Without pupil dilation · 45° FOV: 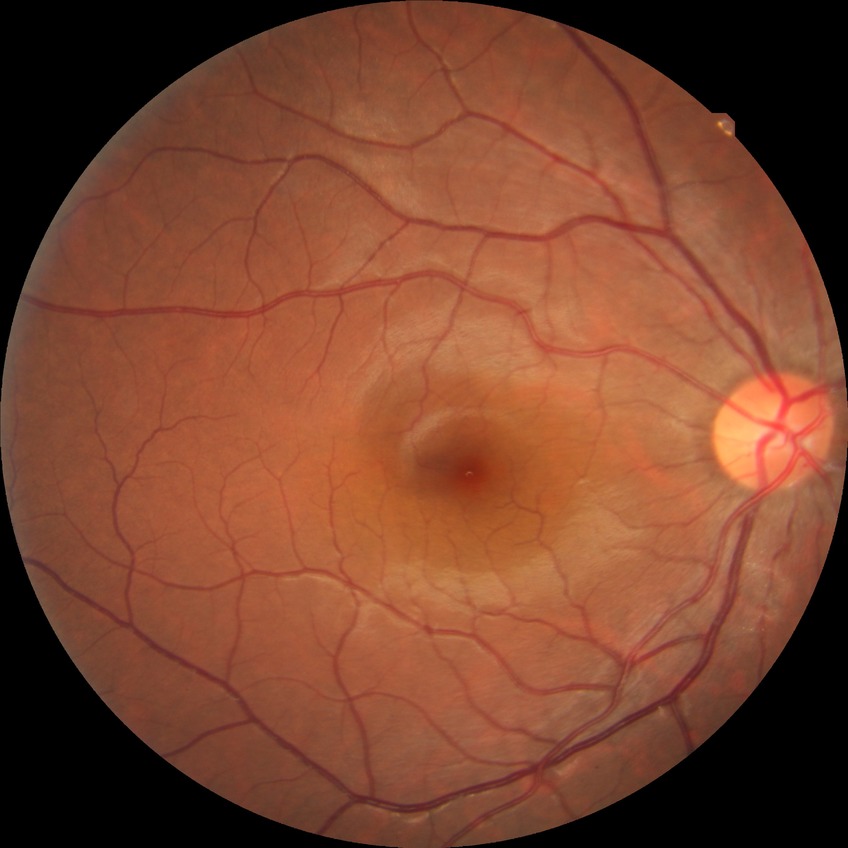

Modified Davis grading: no diabetic retinopathy.